Image size 240x240. Nidek AFC-330:
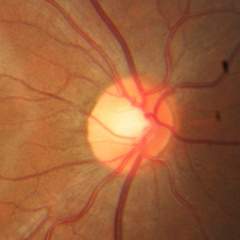 Optic disc appearance consistent with no glaucomatous changes.